Wide-field fundus photograph of an infant · acquired on the Clarity RetCam 3.
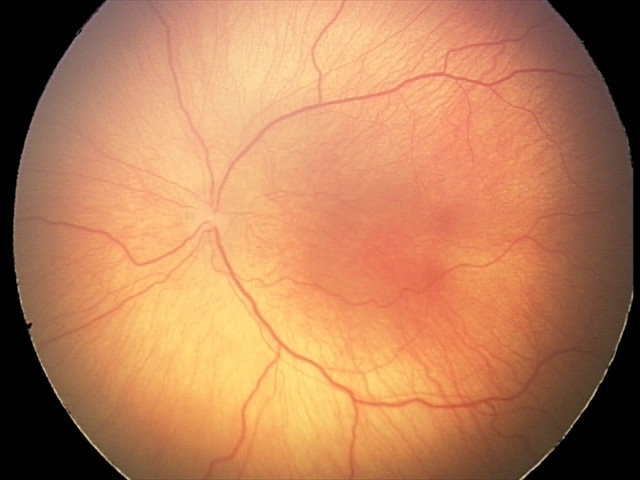
Q: Is plus disease present?
A: no plus disease
Q: What is the screening diagnosis?
A: ROP stage 2 — ridge with height and width at the demarcation line